Wide-field fundus image from infant ROP screening · acquired on the Phoenix ICON:
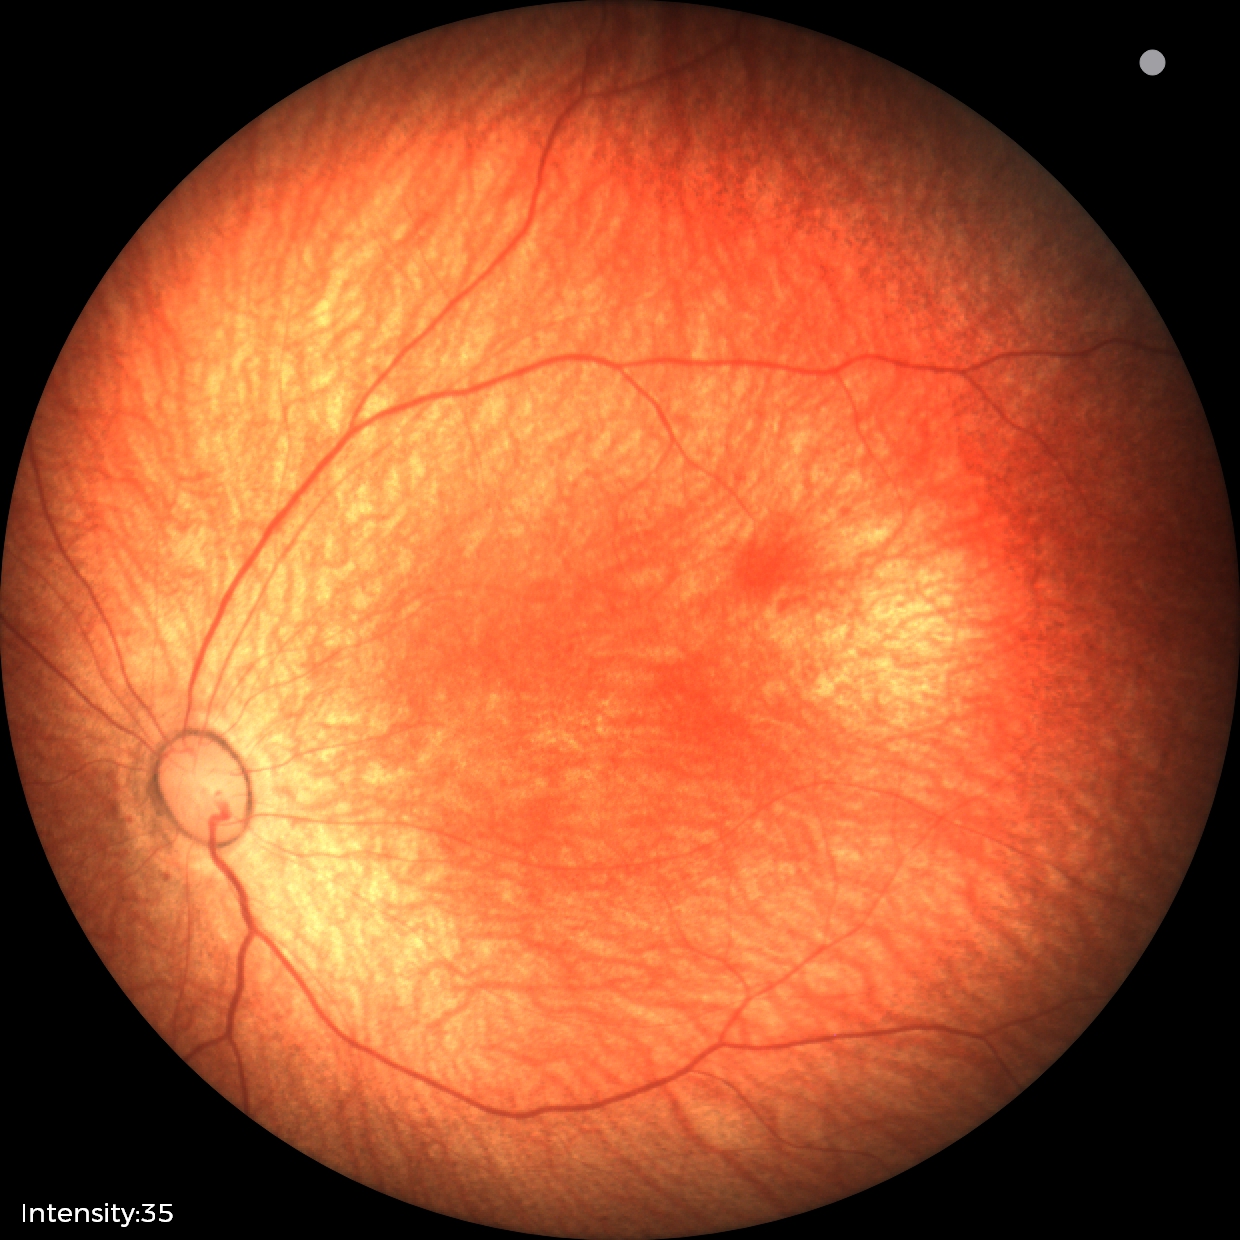

Physiological retinal appearance for postconceptual age.